Wide-field fundus photograph of an infant — 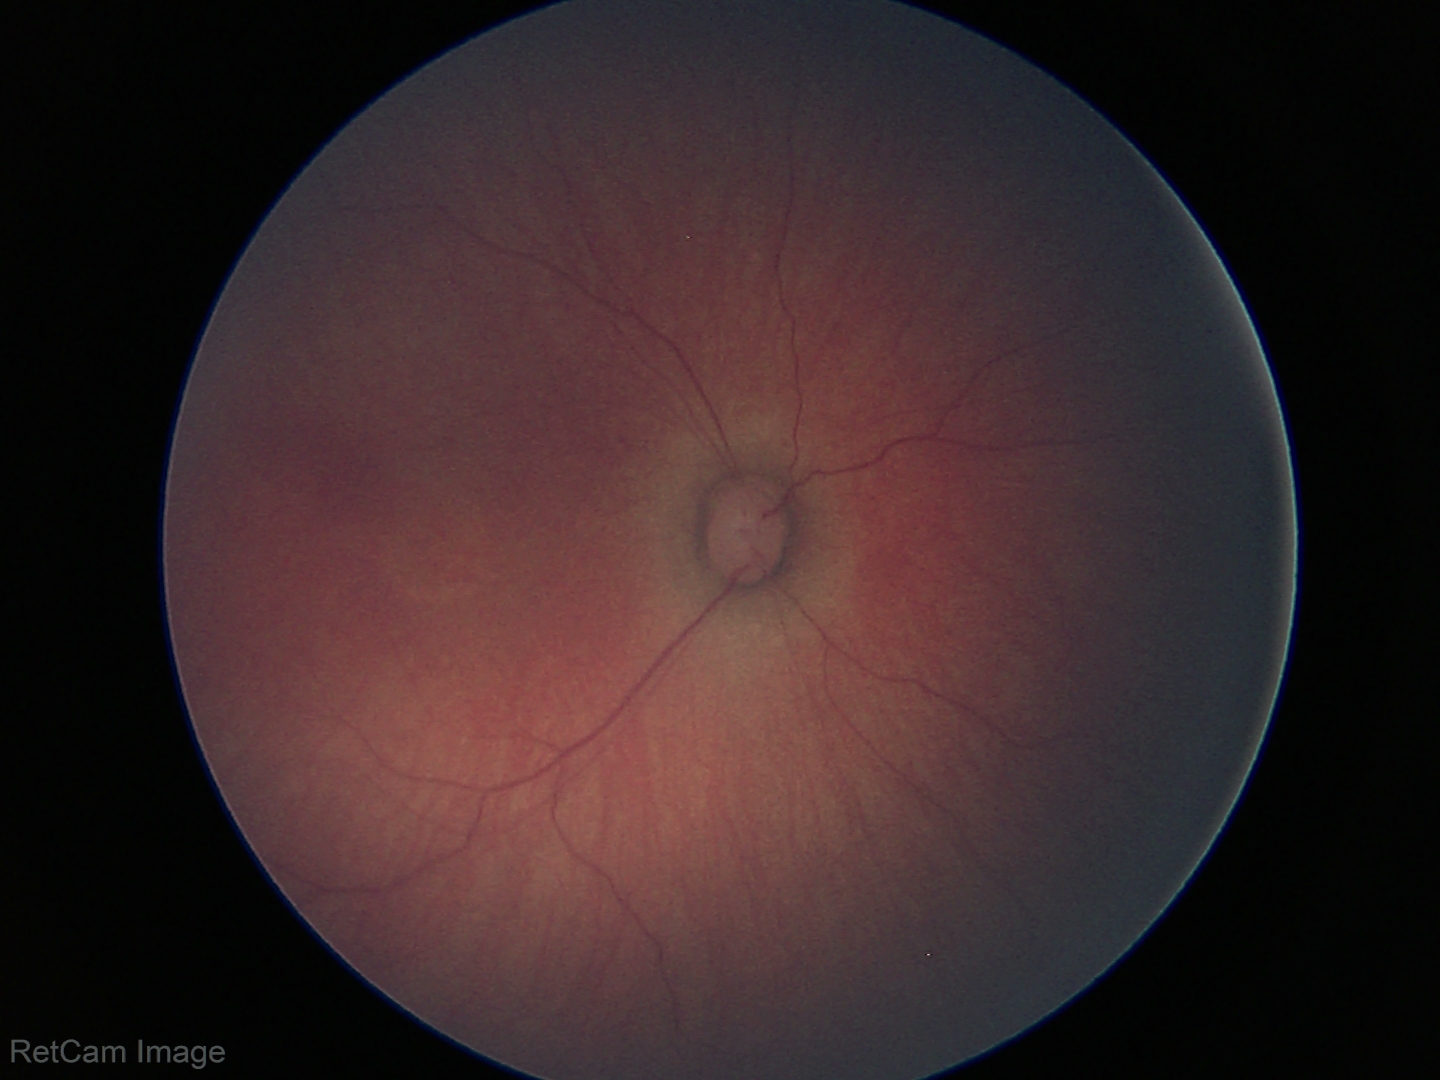

Screening diagnosis: no abnormal retinal findings.